2048x1536px. Color fundus photograph:
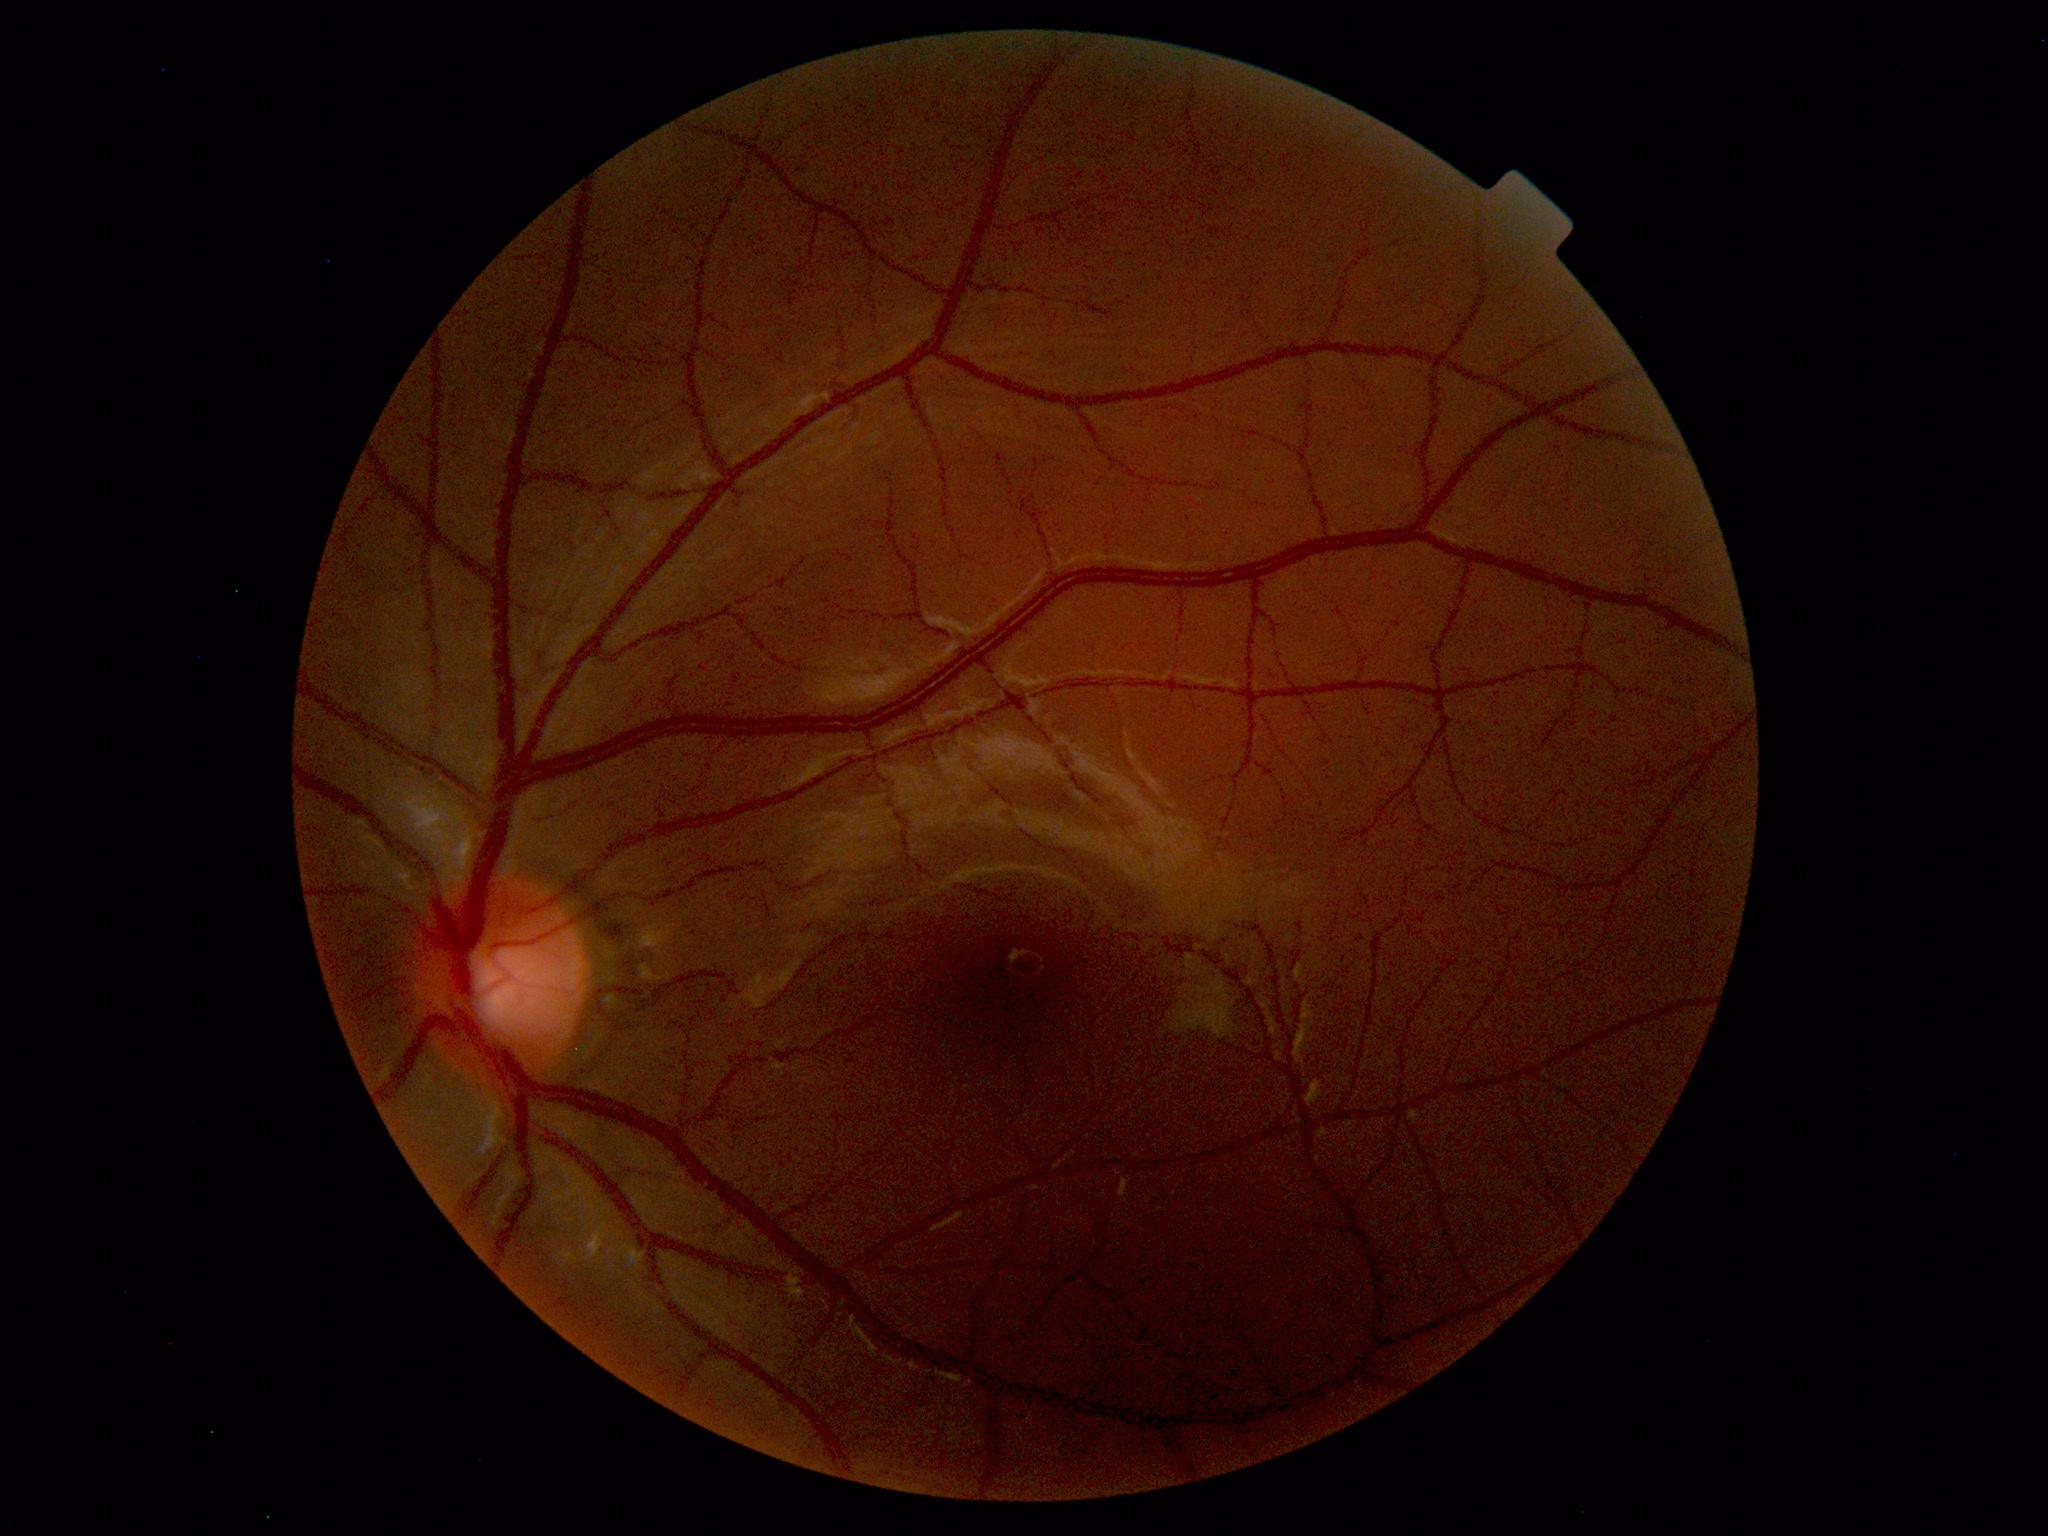
No retinal pathology identified.